CFP.
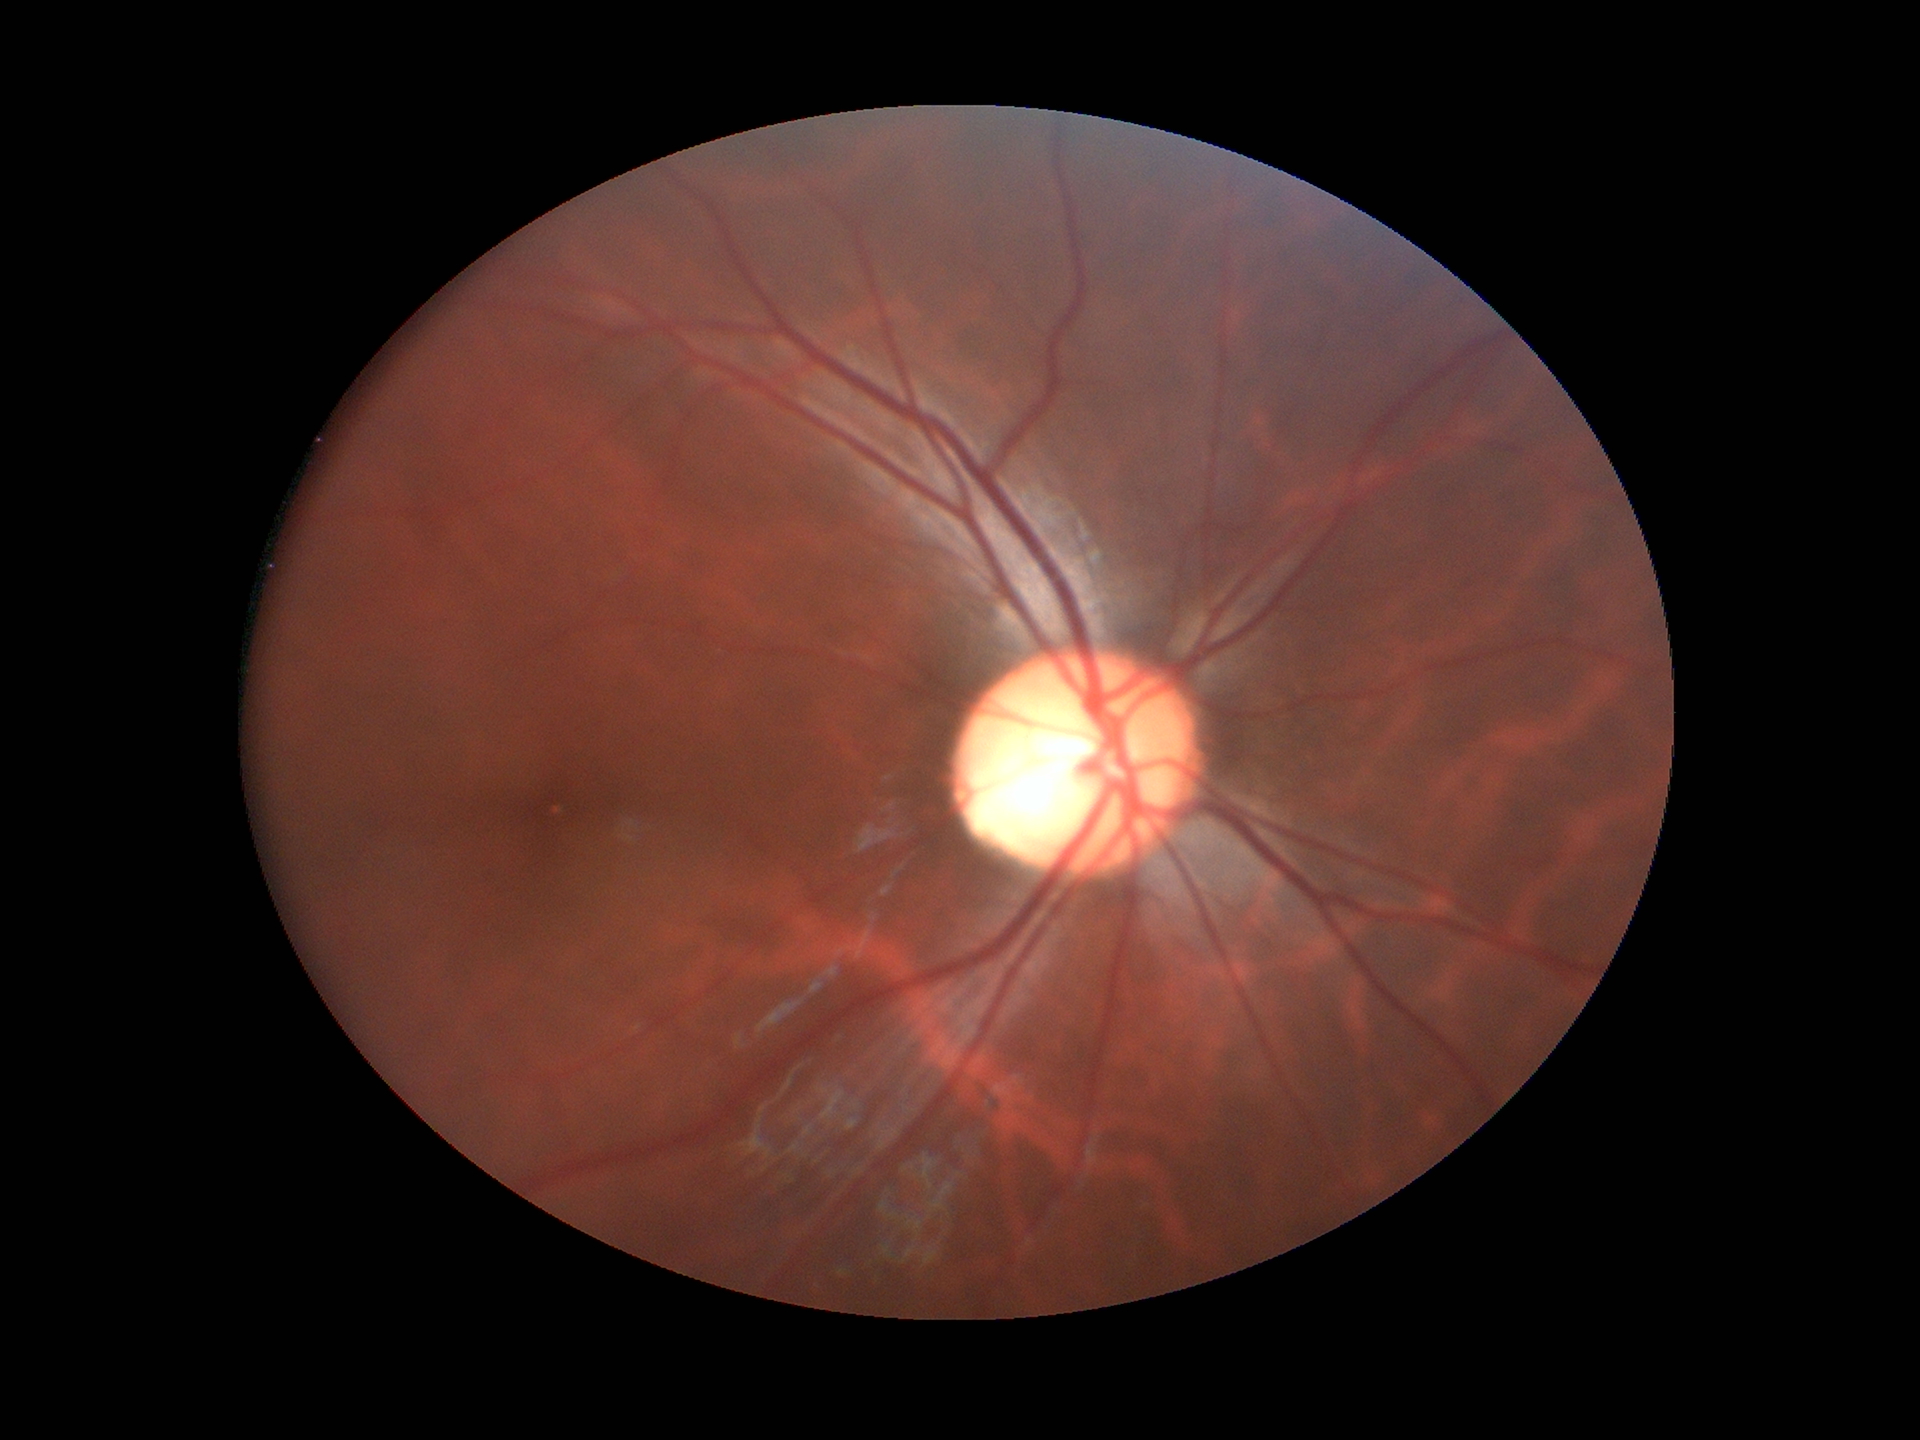
Vertical C/D ratio (VCDR) is 0.63.
Area CDR (ACDR): 0.38.
Findings suspicious for glaucoma.